Remidio Fundus on Phone: 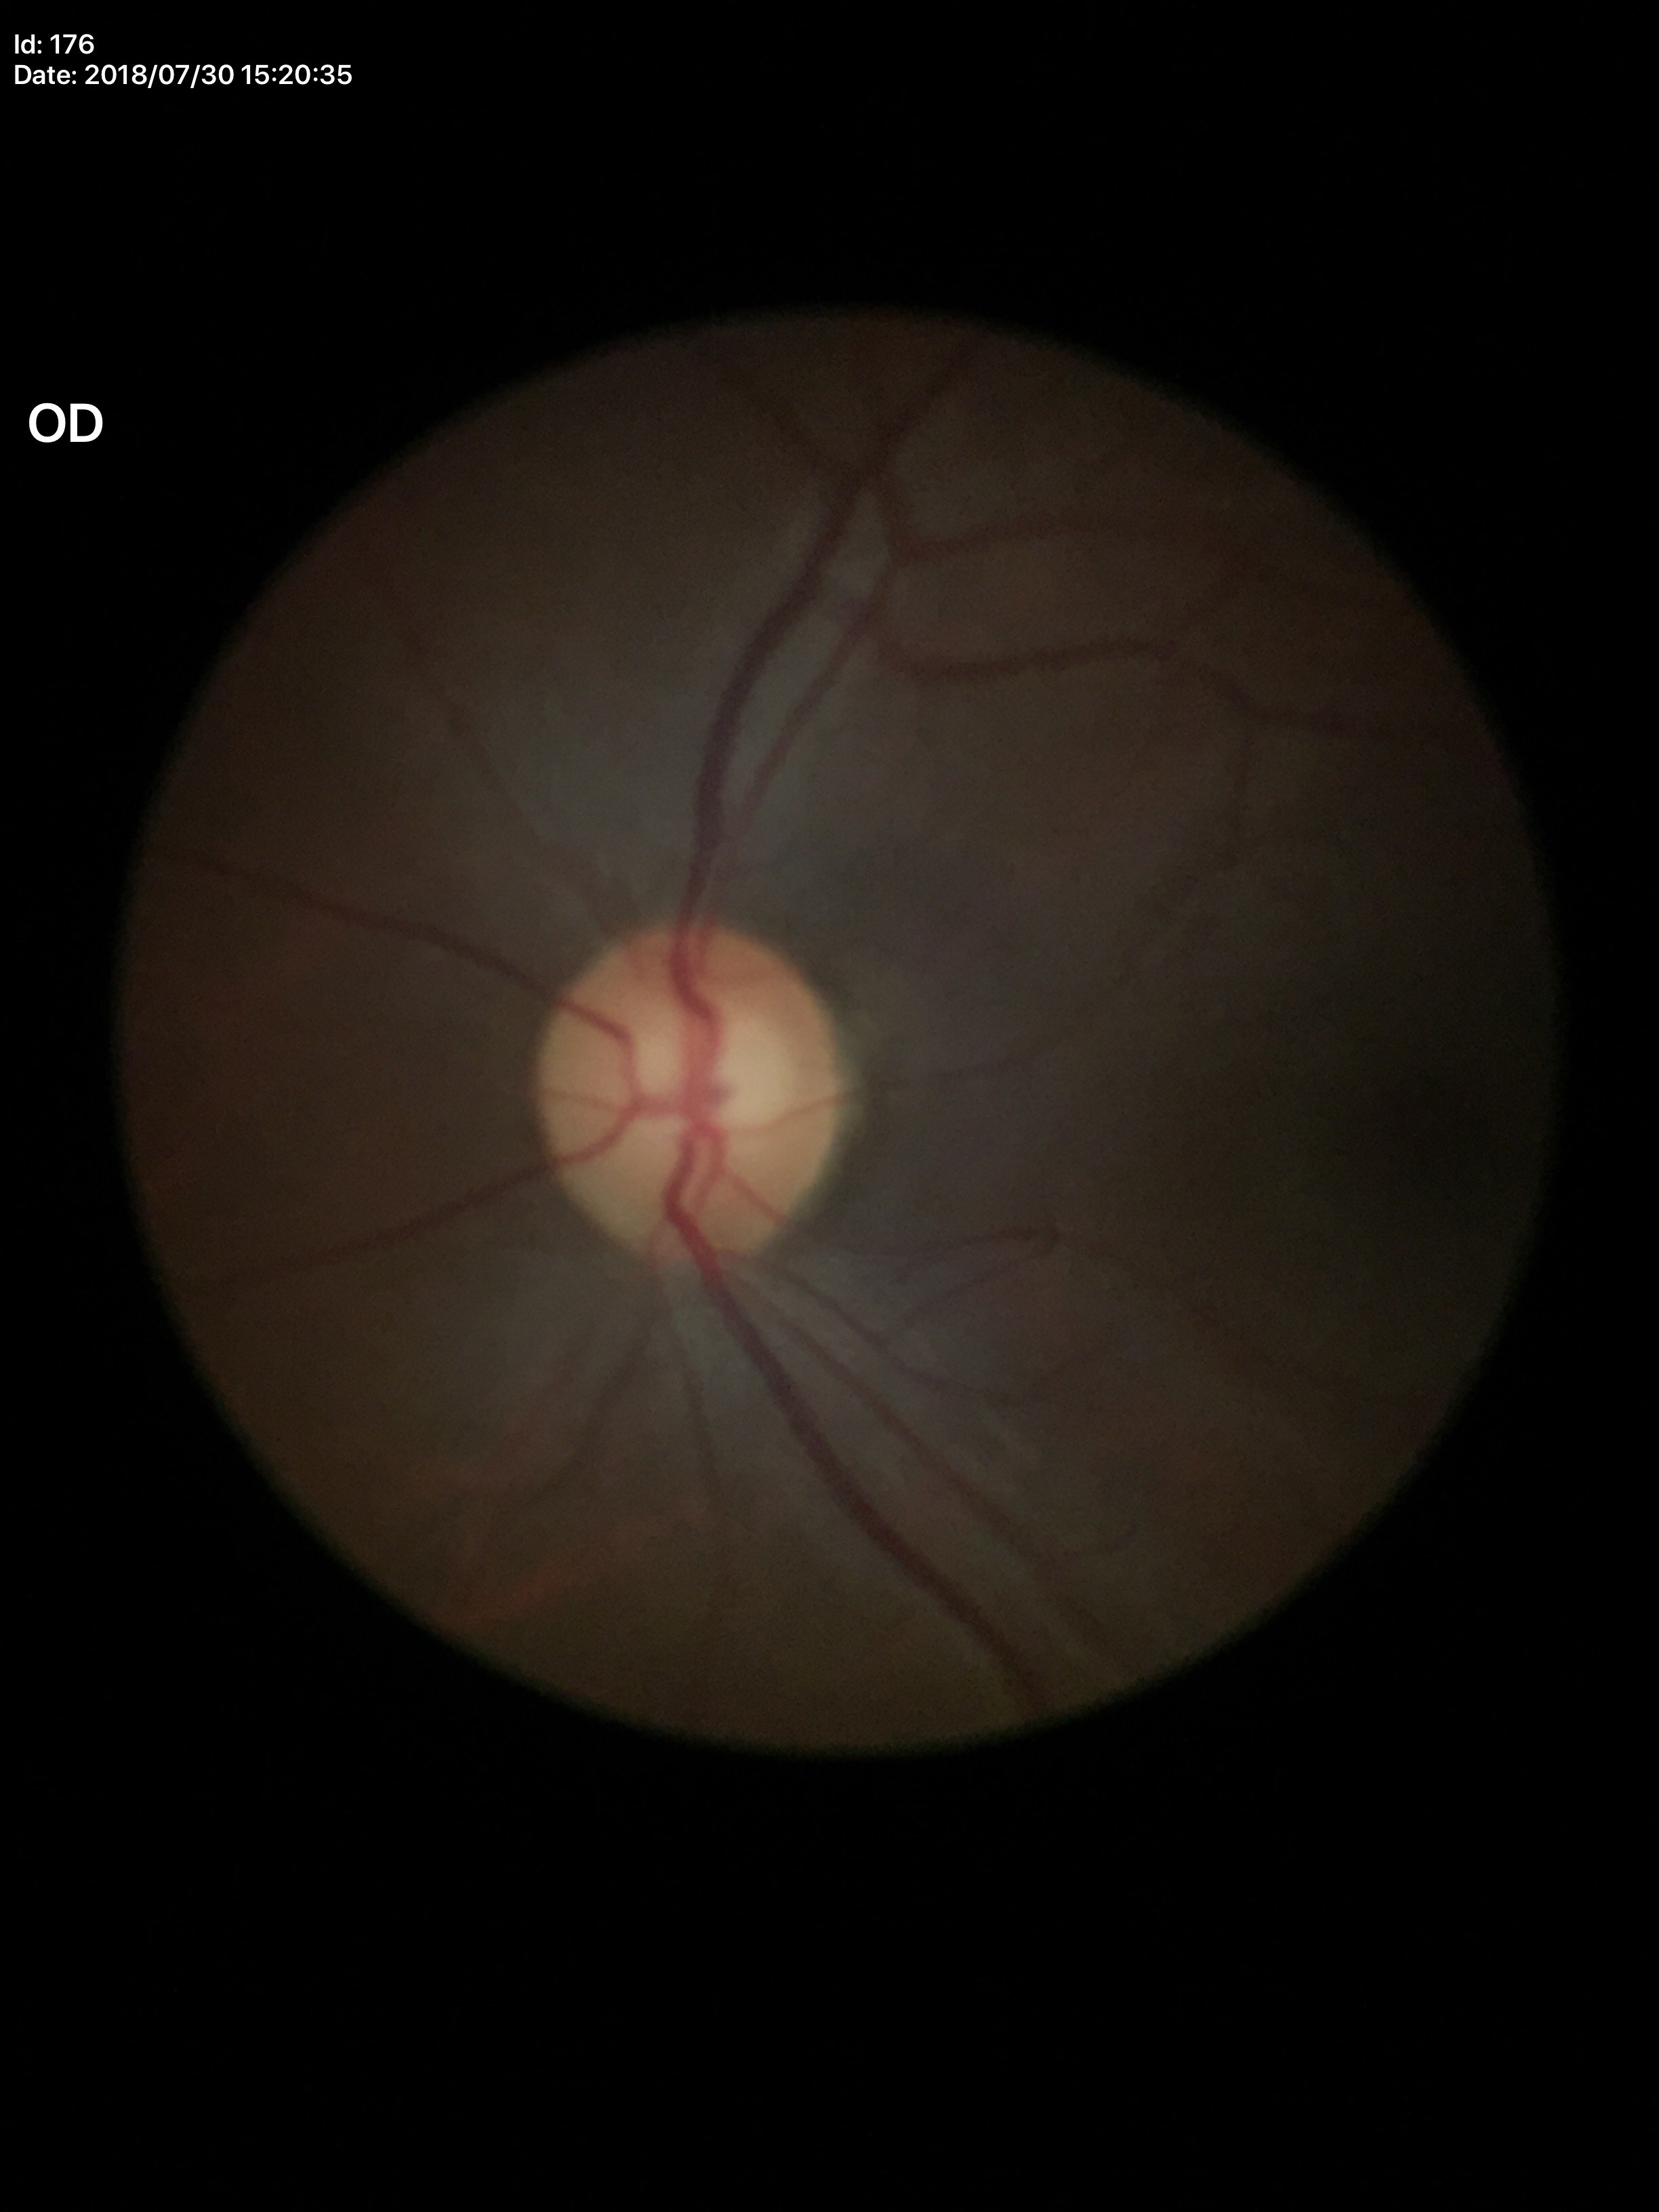
HCDR of 0.62. VCDR is 0.58. Glaucoma screening: negative. ACDR: 0.36.